CFP, 2048 x 1536 pixels
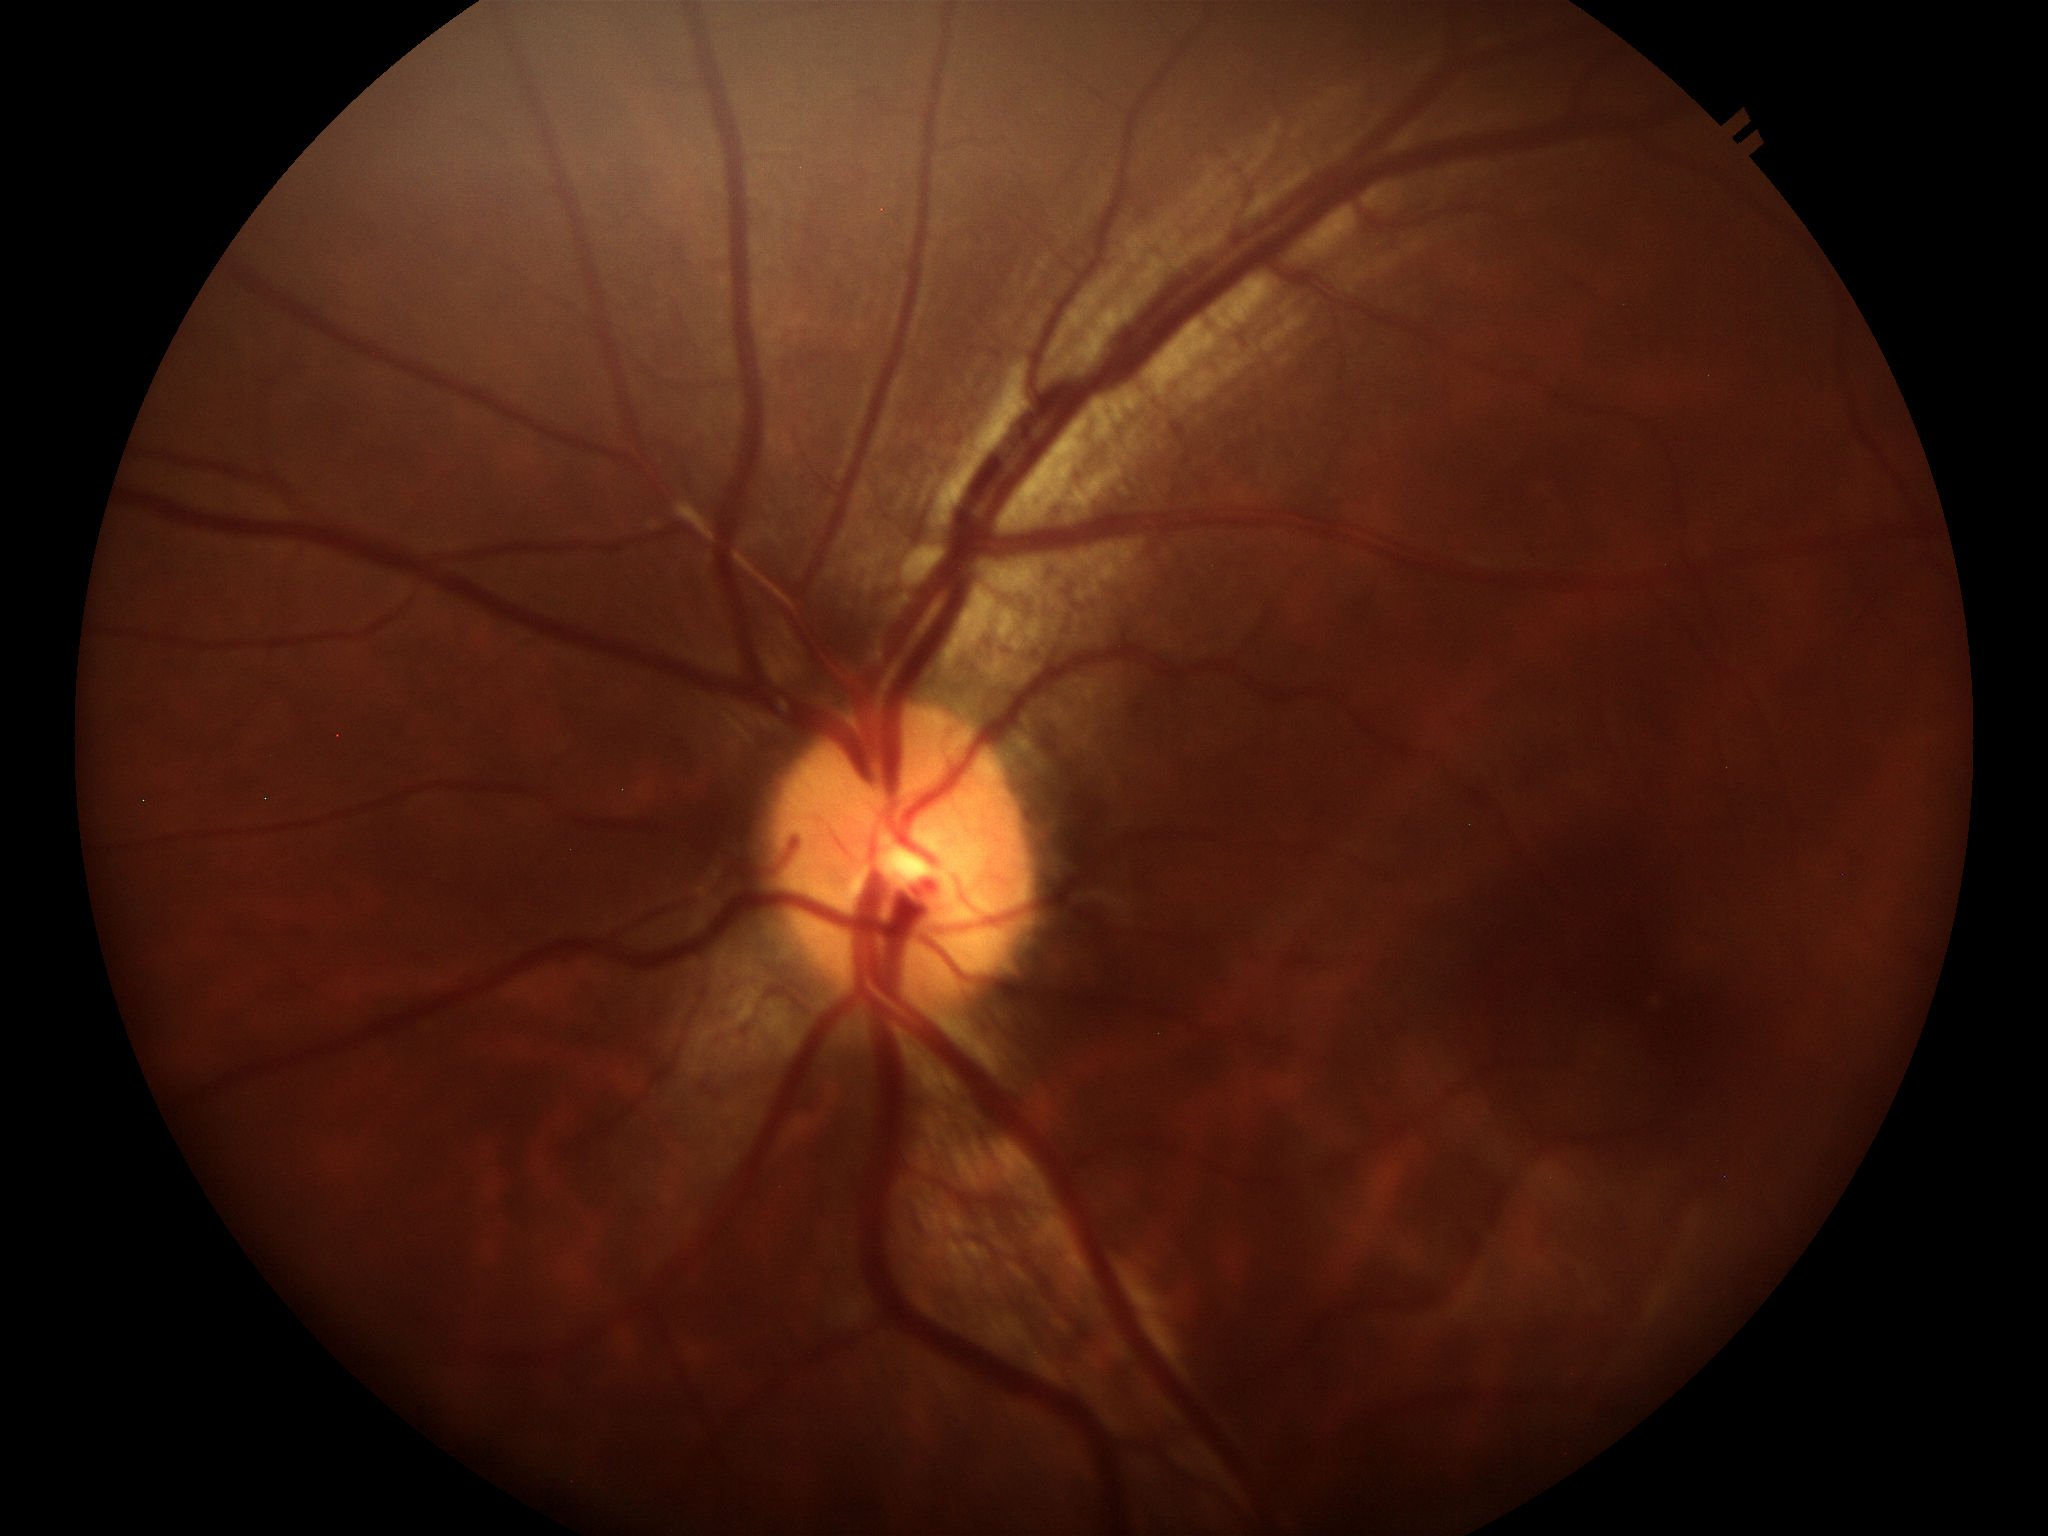

vertical CDR (VCDR)=0.47
Glaucoma assessment=negative (all 5 graders called normal)